CFP — 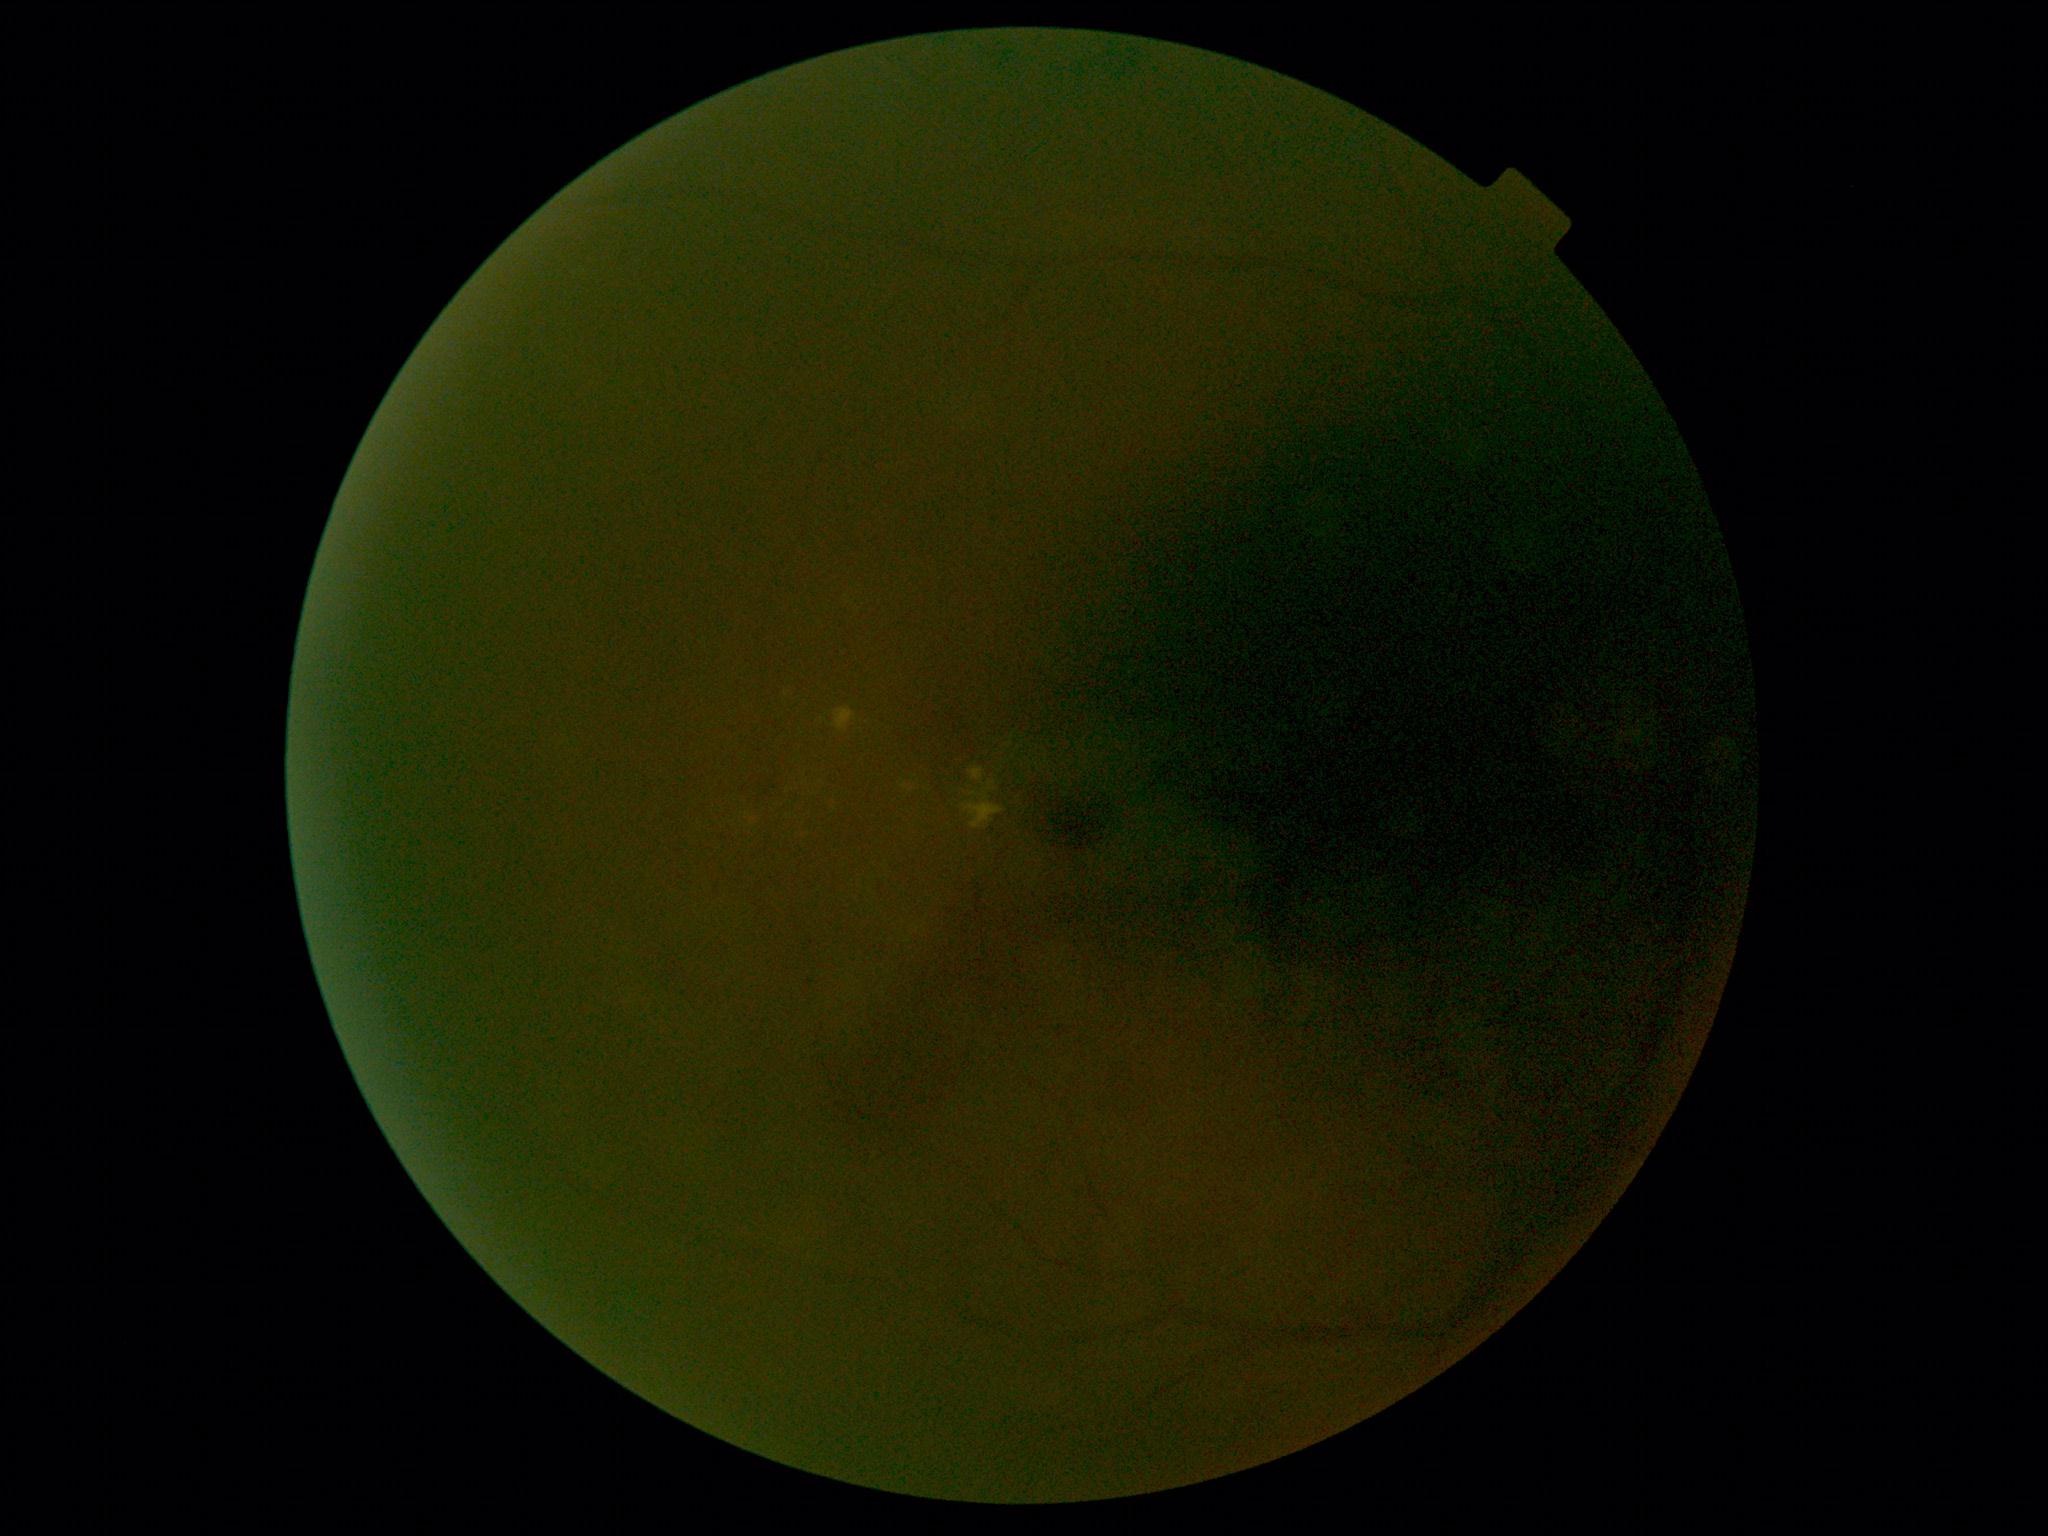 Diabetic retinopathy grade is 2.